Wide-field fundus image from infant ROP screening:
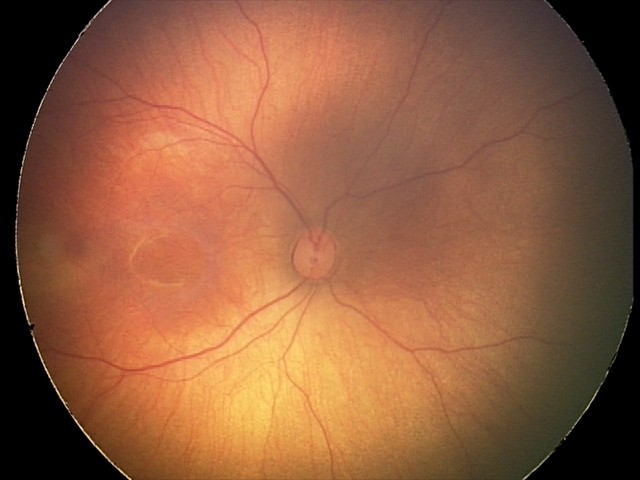 No retinal pathology identified on screening.